Undilated pupil; FOV: 30 degrees — 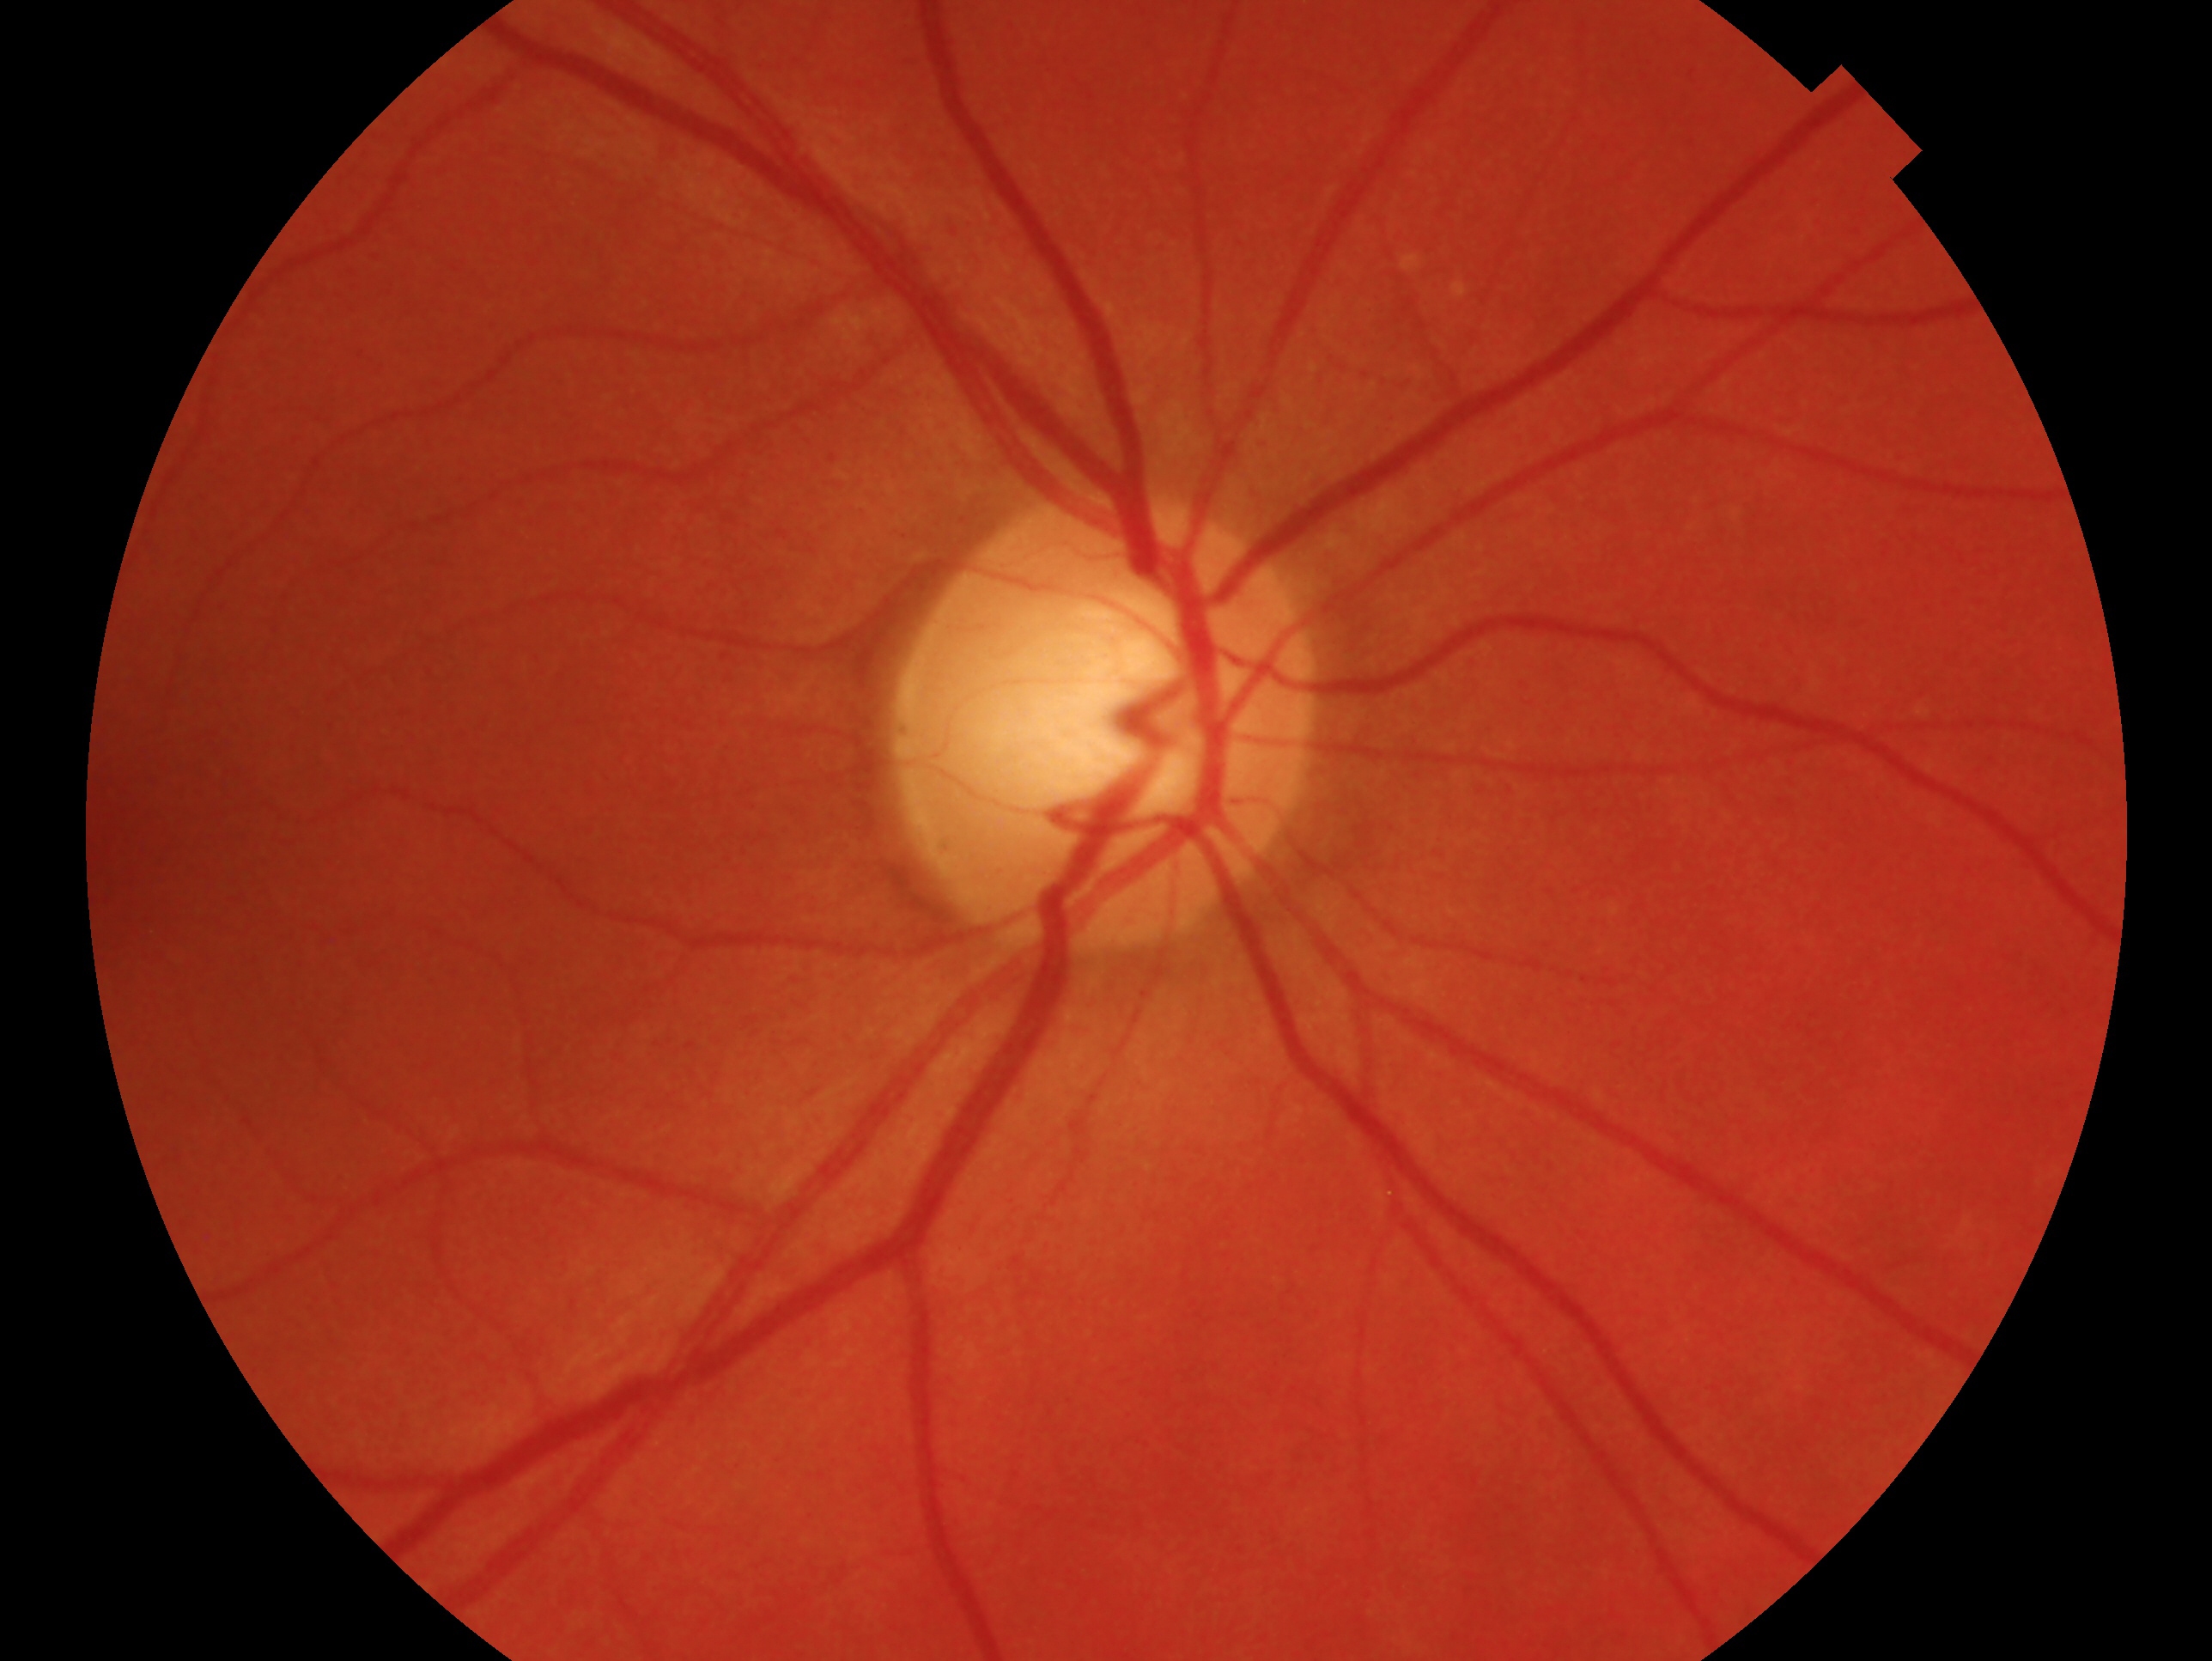
Findings:
• impression · negative for glaucoma — no clinical evidence of glaucoma in this eye
• eye · OD